45° field of view, fundus photo, 2144x1424 — 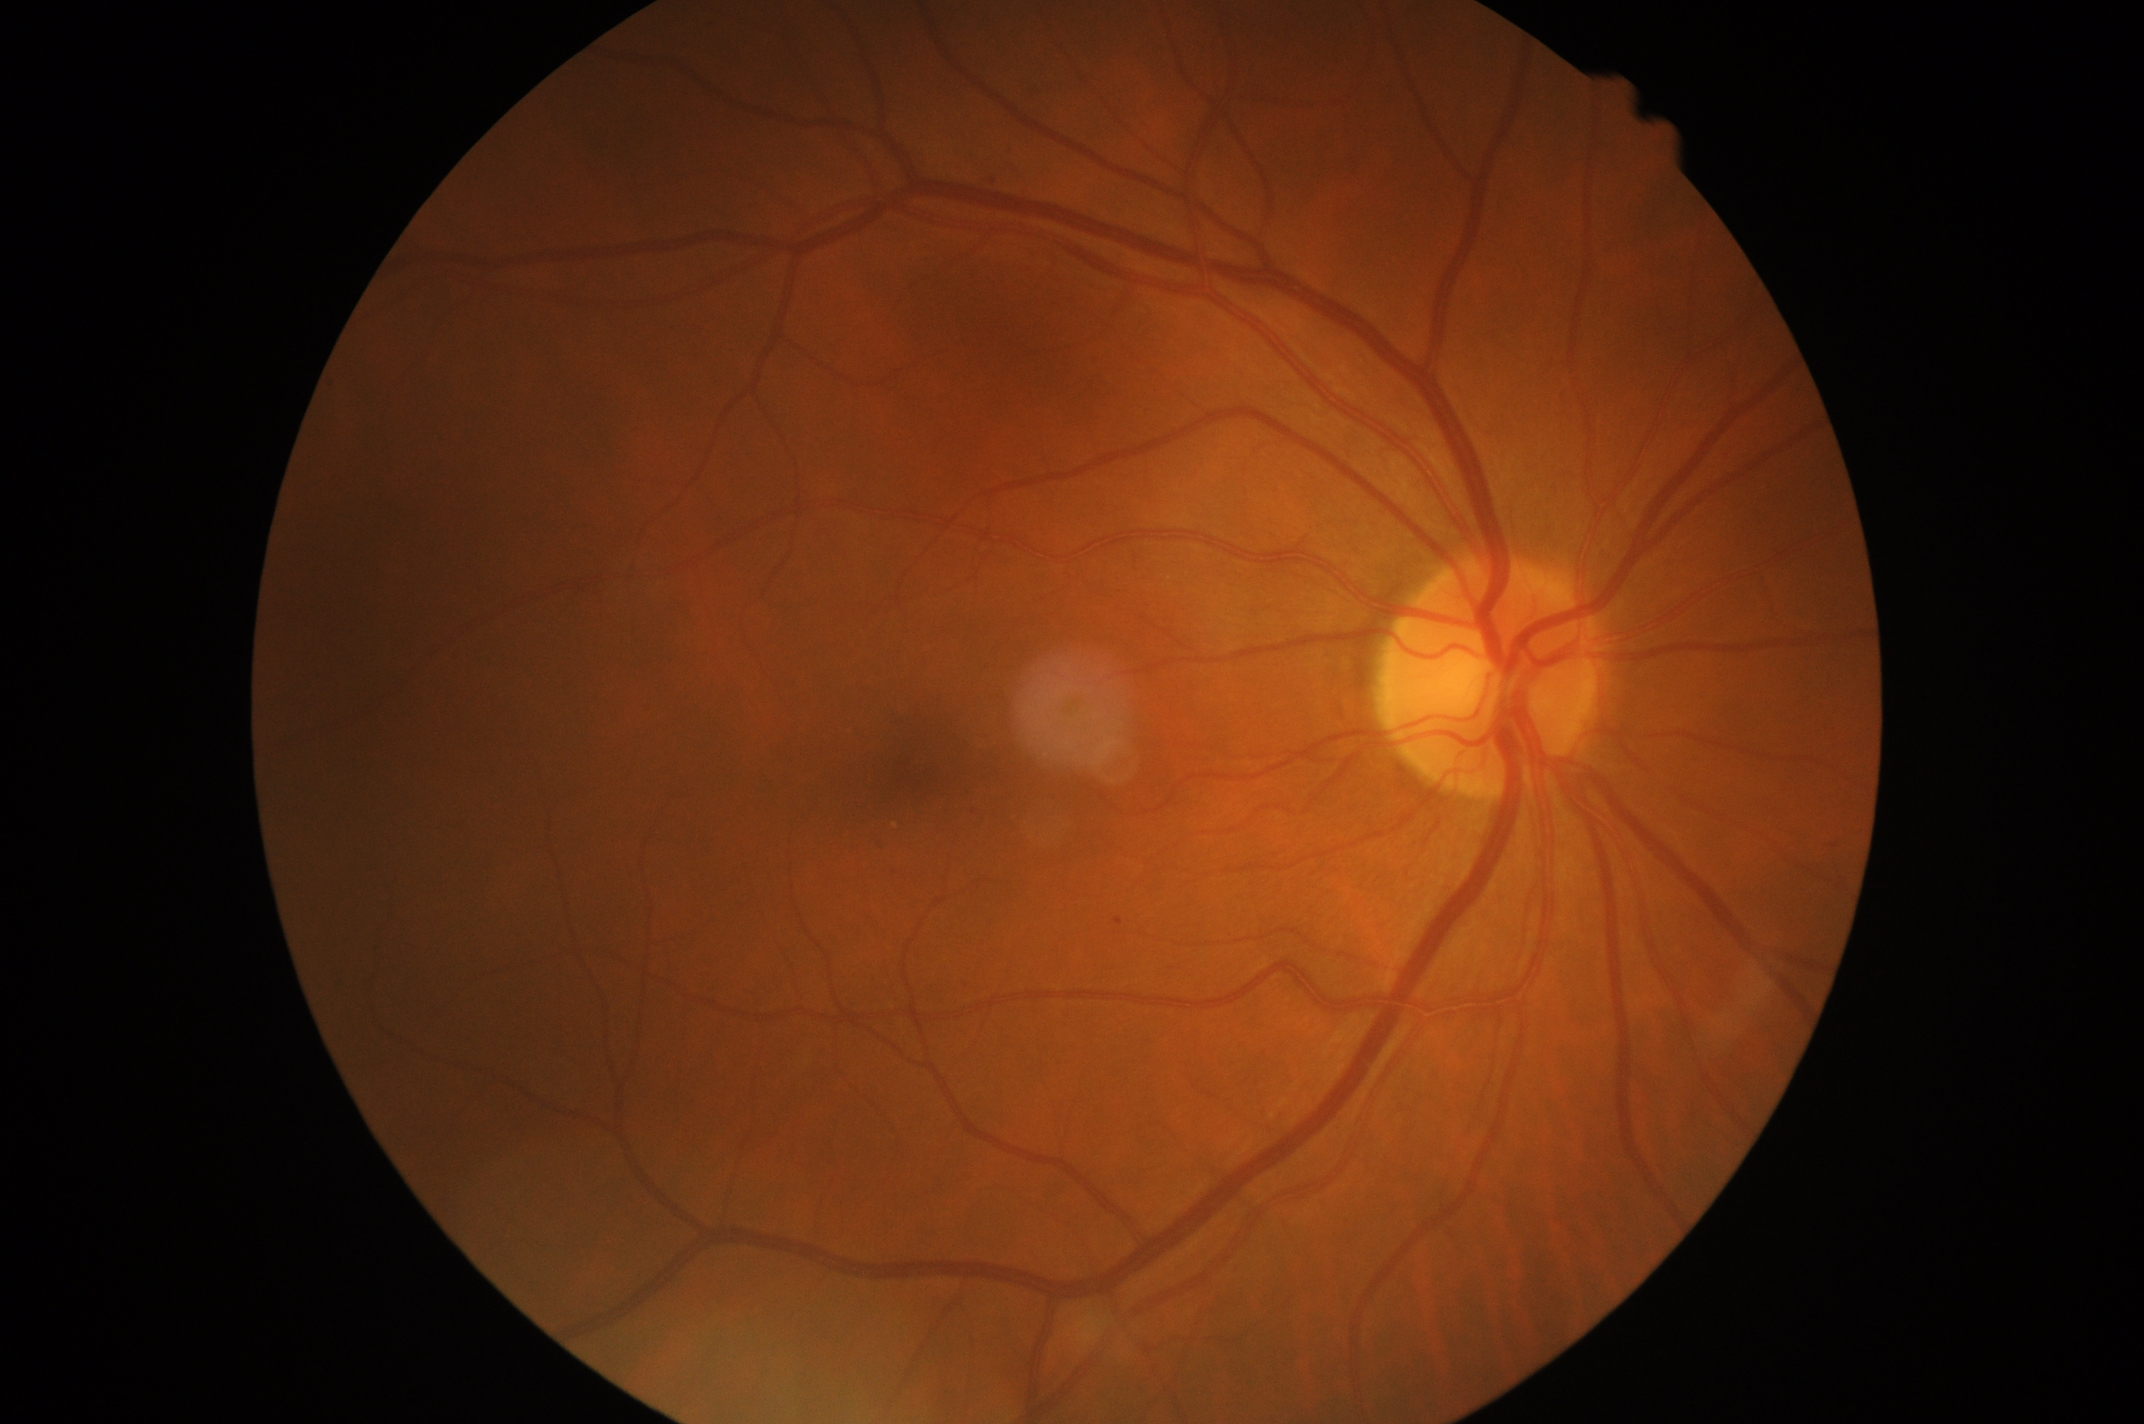
Diabetic retinopathy (DR) is 1.